Infant wide-field retinal image.
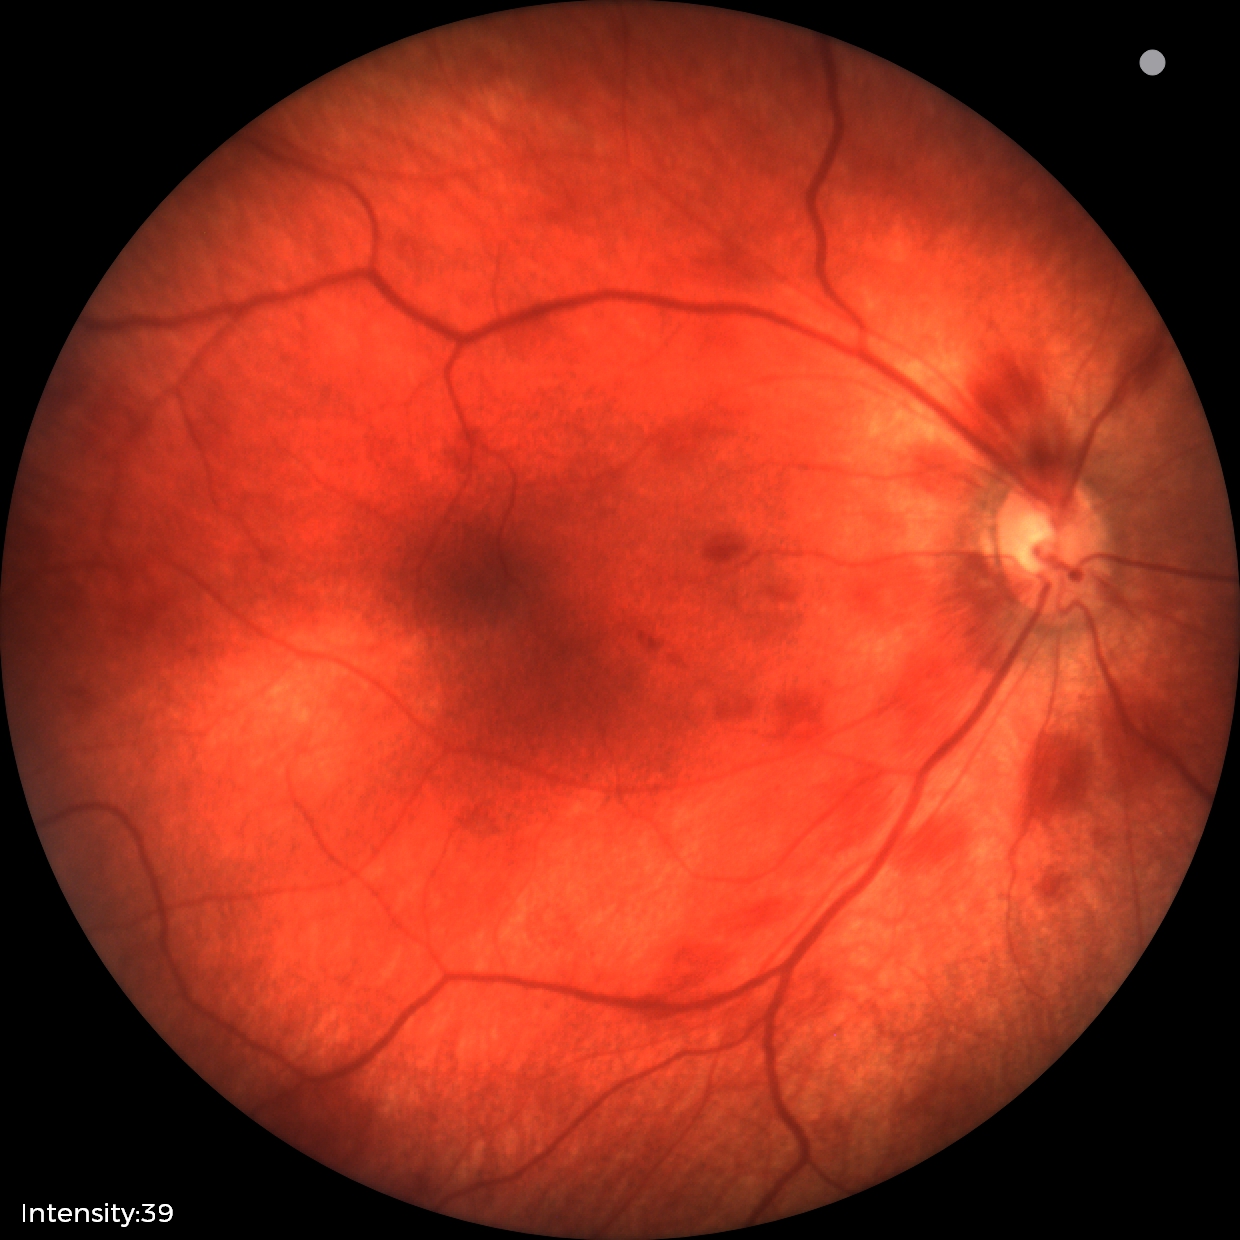
From an examination with diagnosis of retinal hemorrhages.